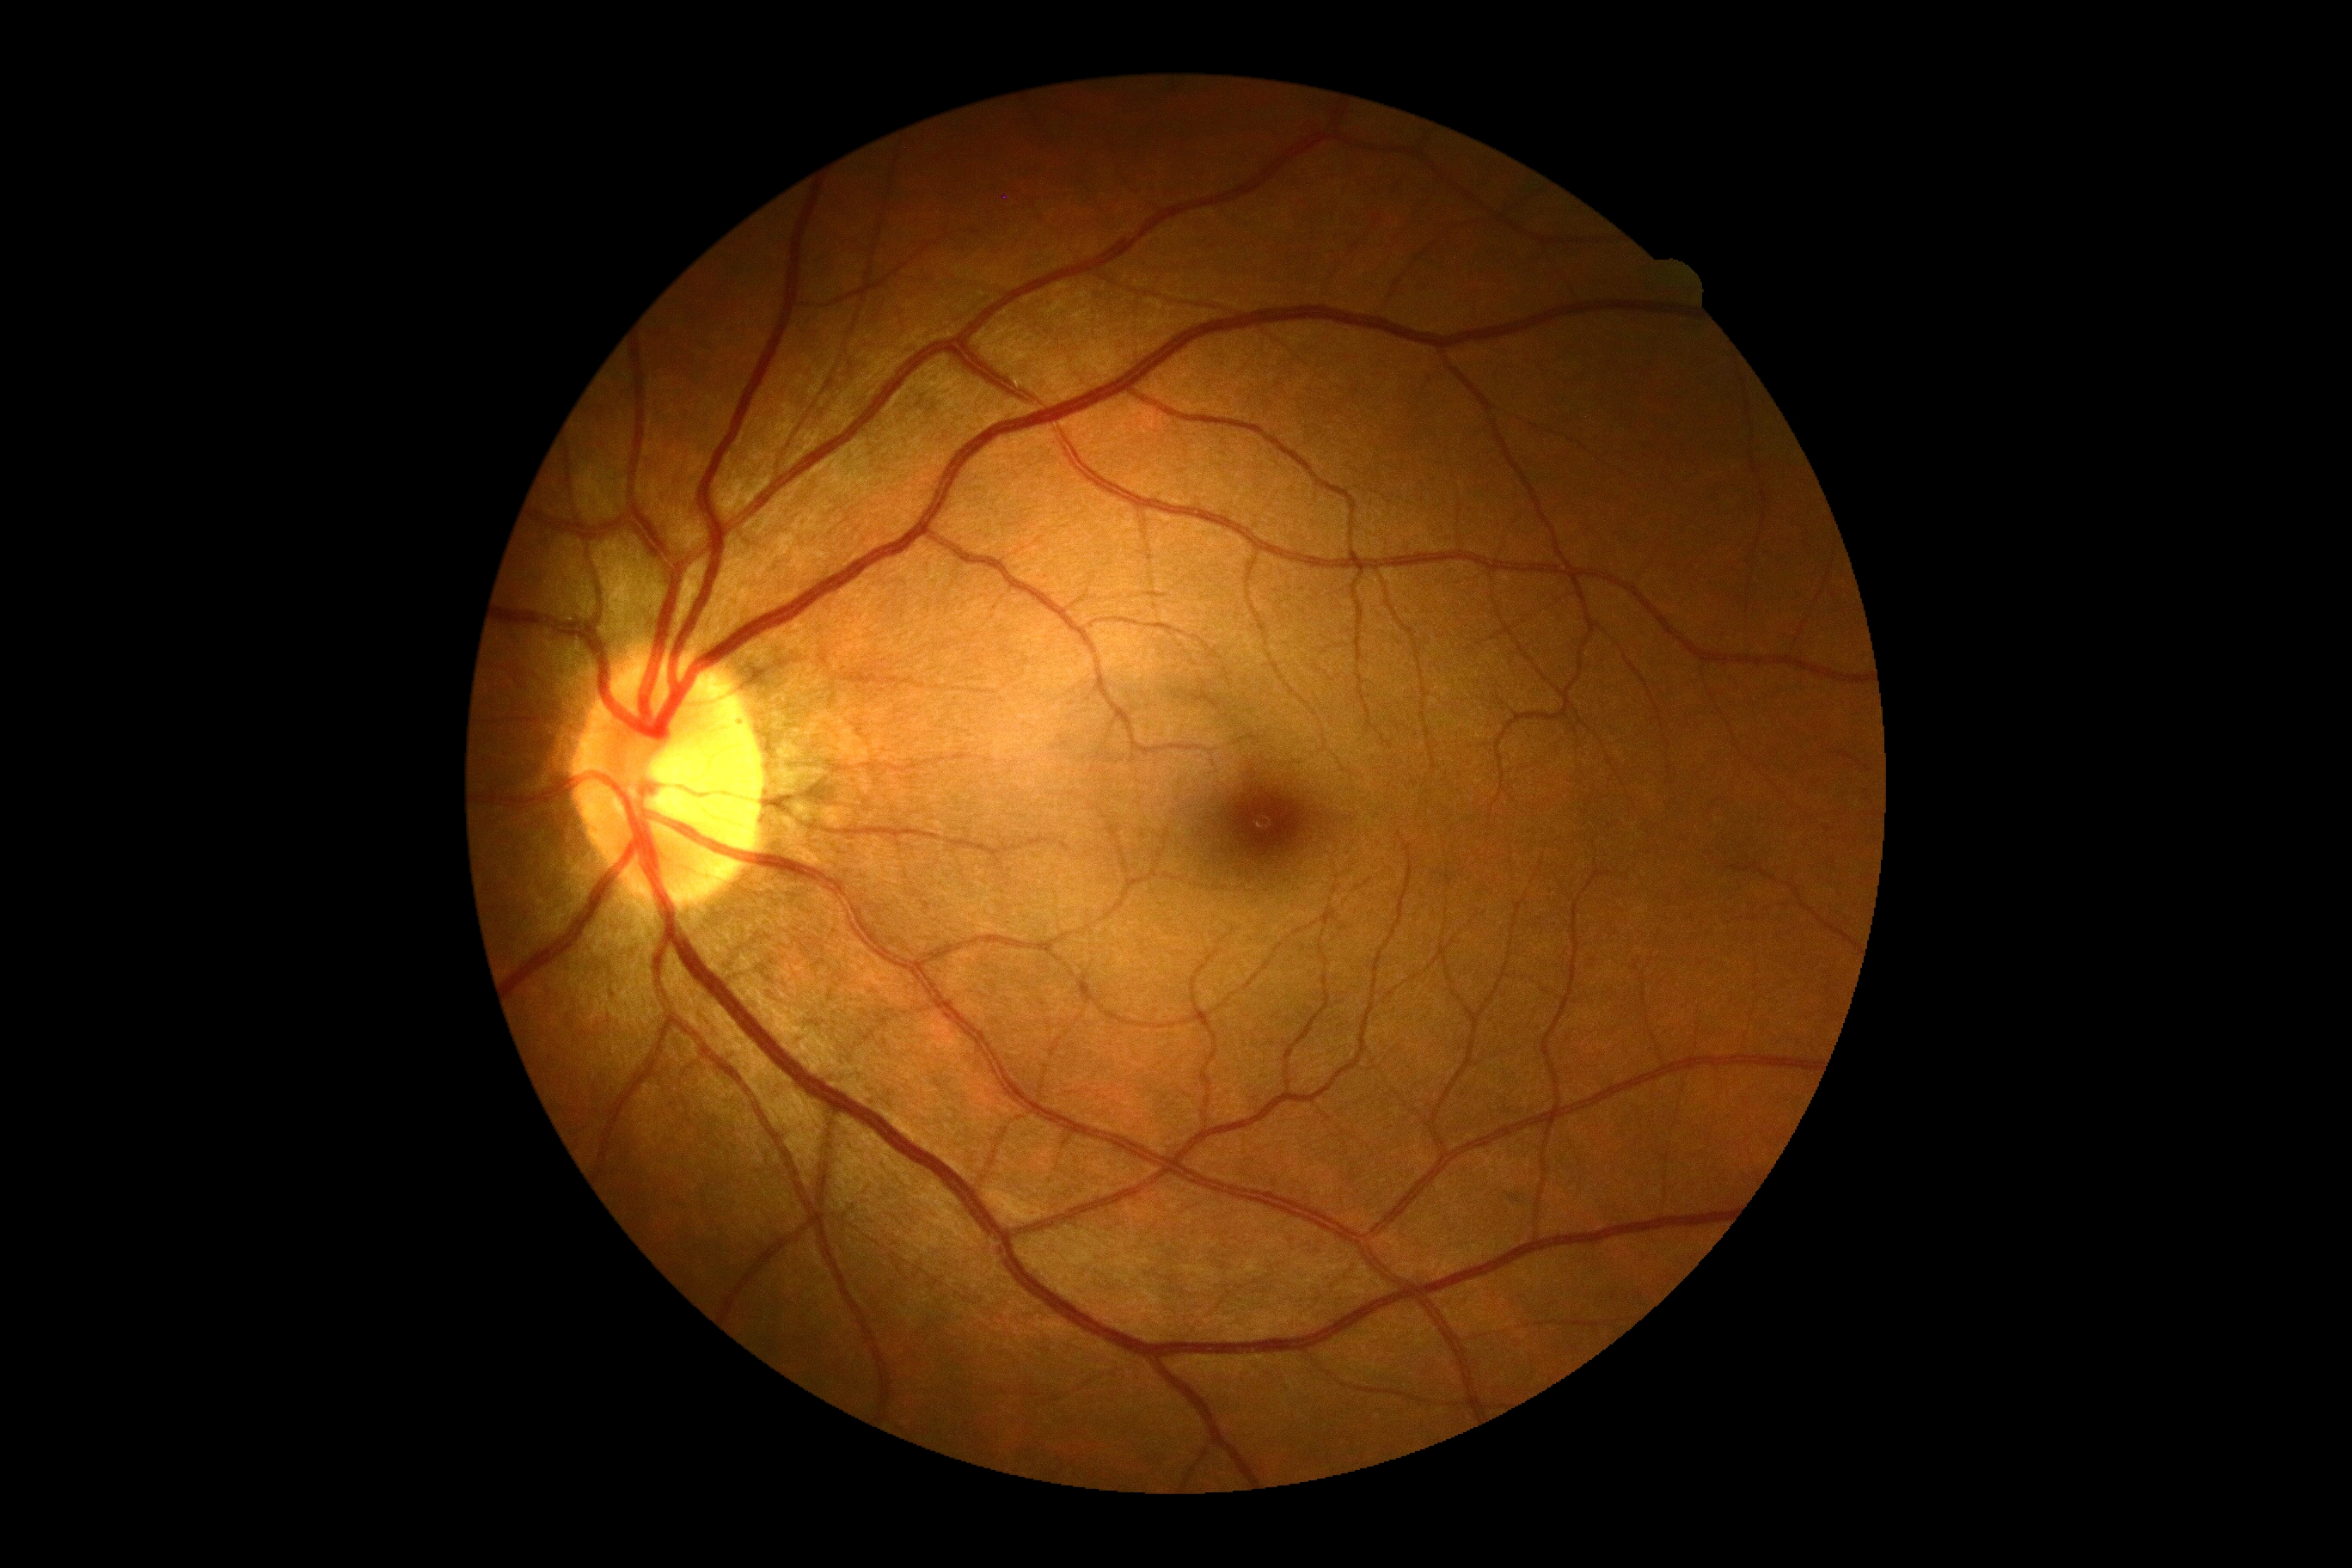 diabetic retinopathy: no apparent retinopathy (grade 0).